2352 by 1568 pixels. CFP — 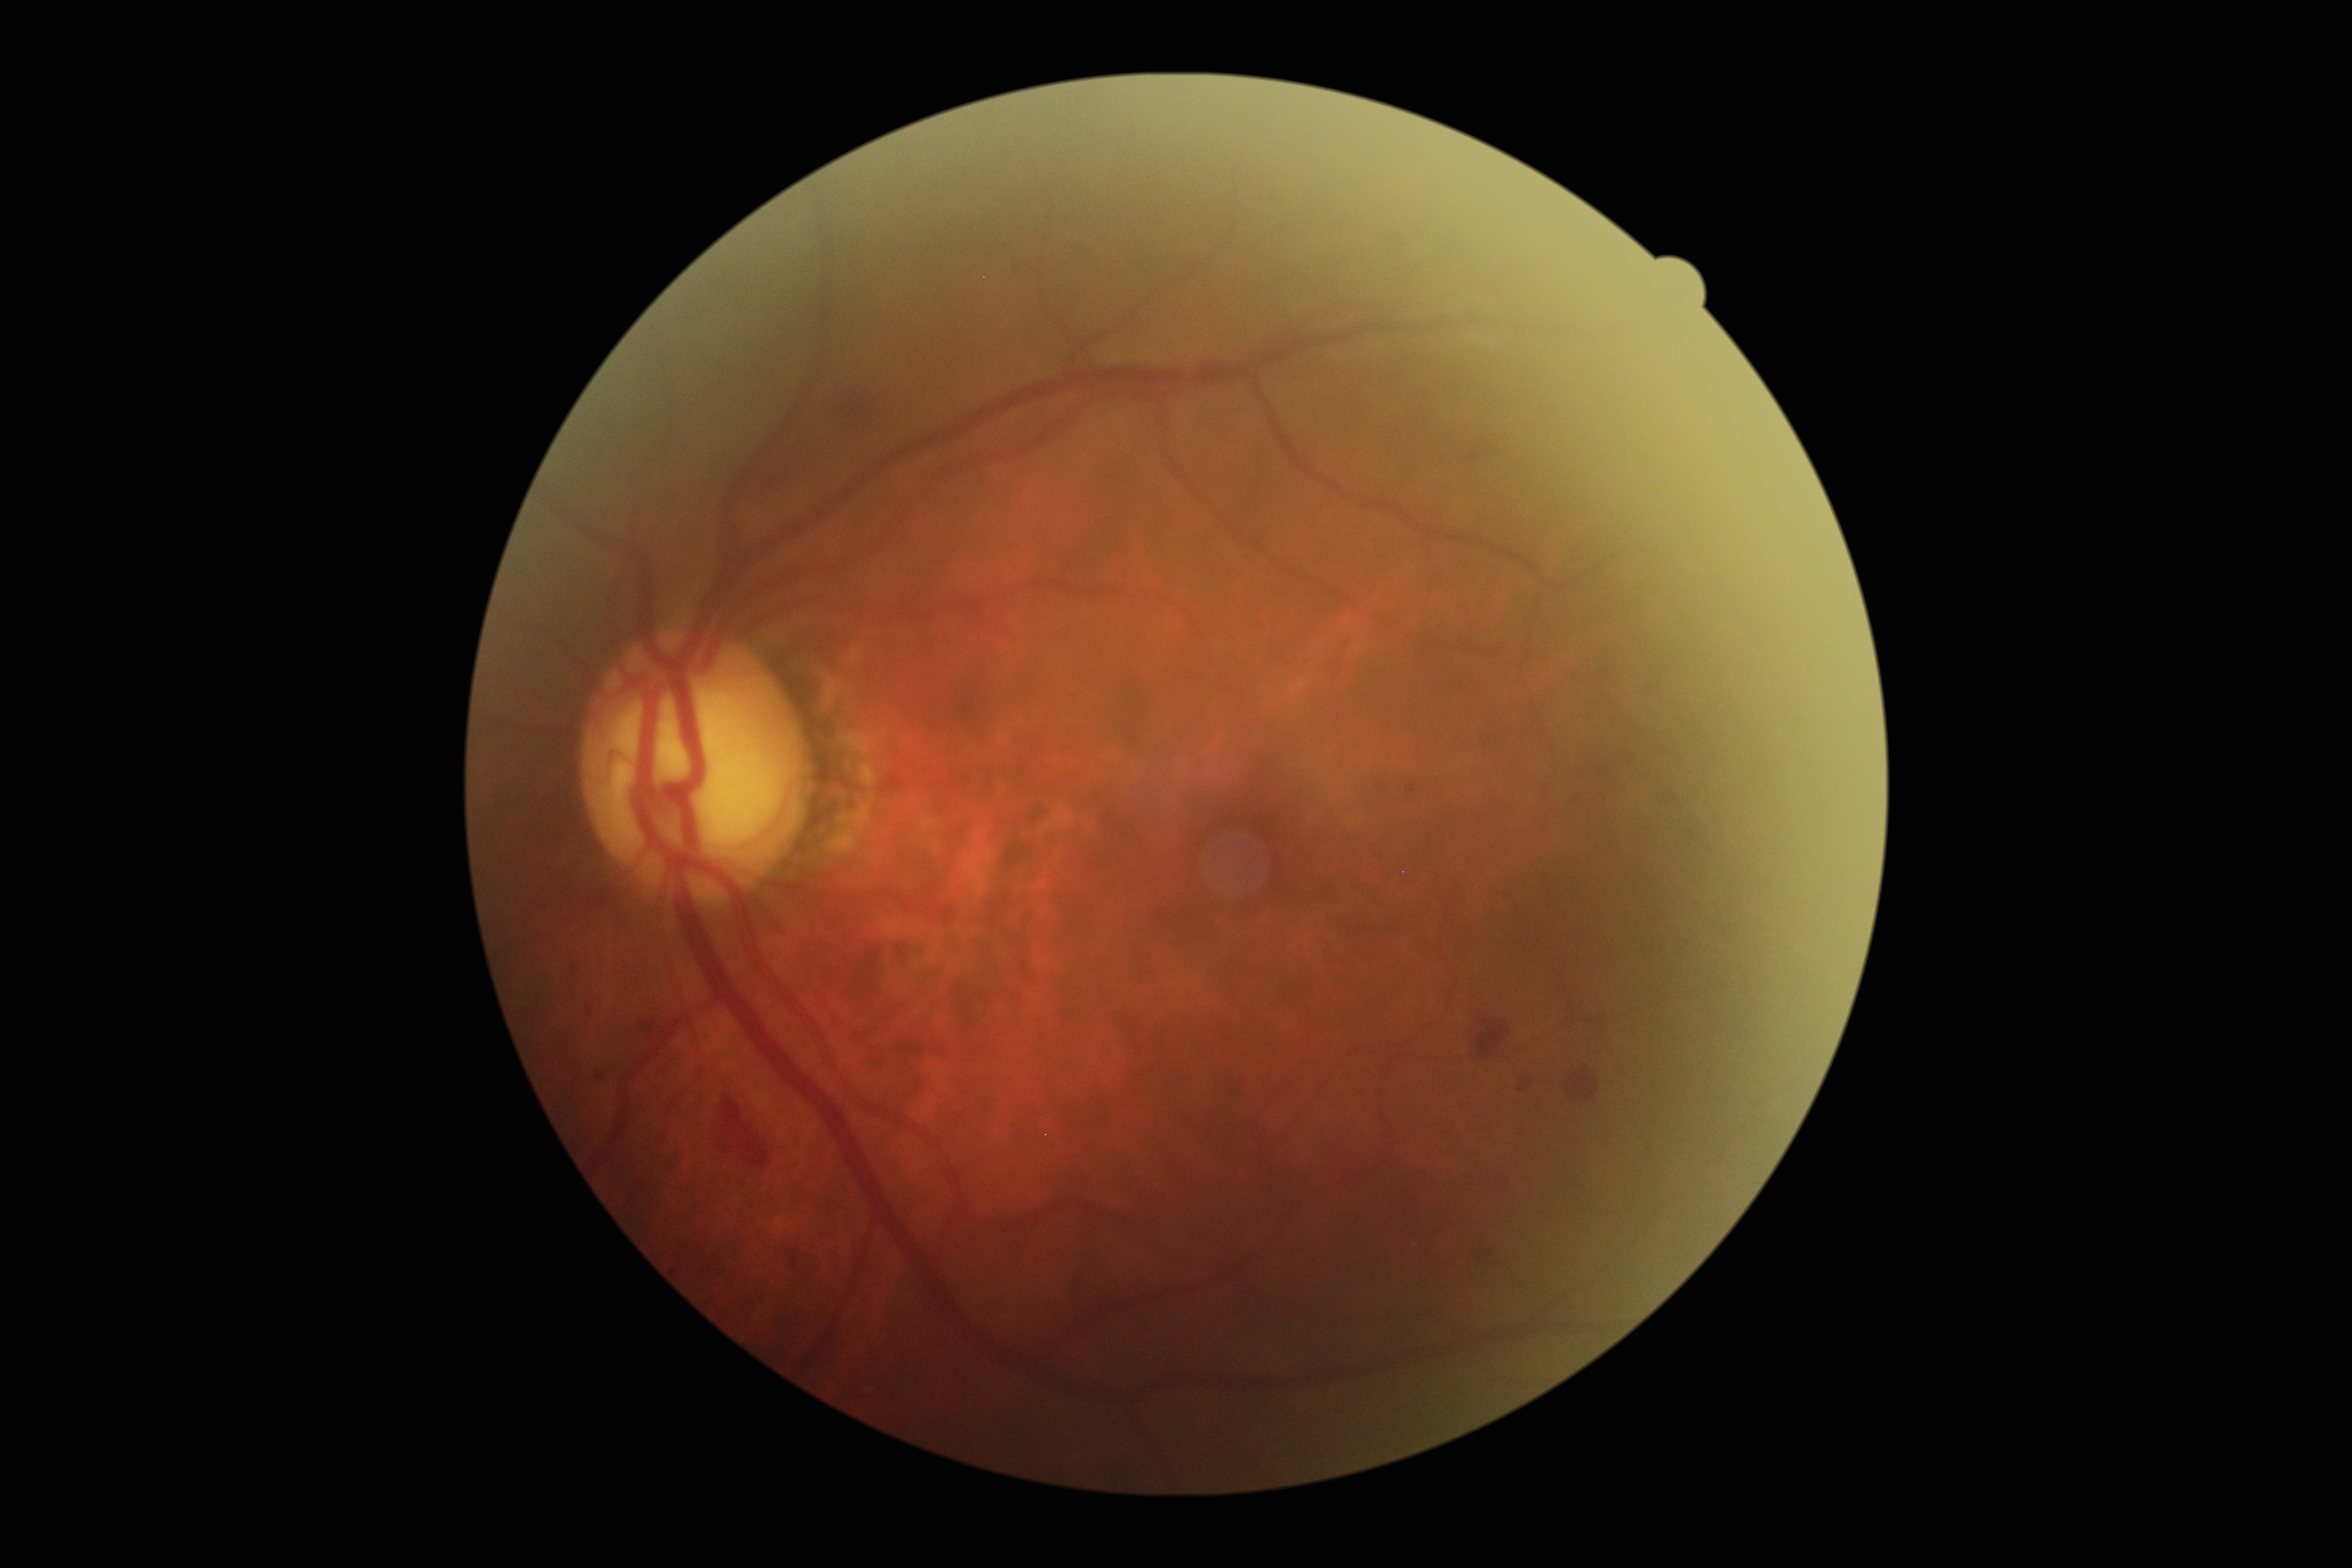 Findings:
• diabetic retinopathy (DR): grade 2 (moderate NPDR) — more than just microaneurysms but less than severe NPDR